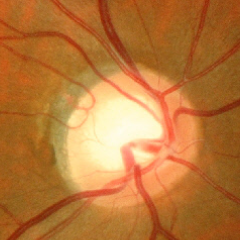
Q: Is glaucoma present?
A: No glaucomatous optic neuropathy.